Infant wide-field fundus photograph. Clarity RetCam 3, 130° FOV. 640 by 480 pixels: 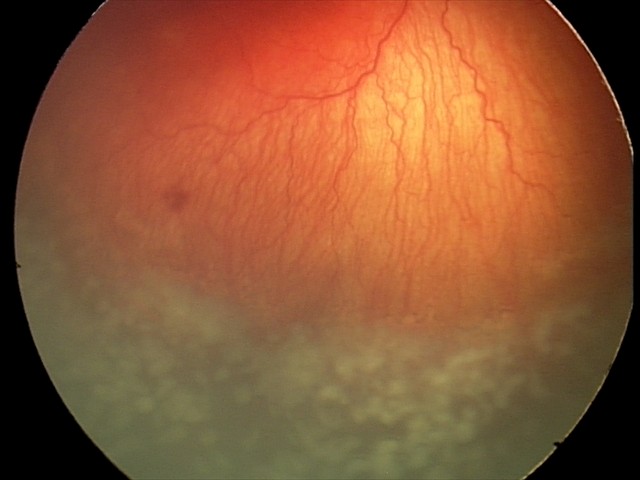 Impression: A-ROP (aggressive ROP) — rapidly progressive severe ROP with prominent plus disease, often without classic stage progression; plus disease: present.